1440x1080px · wide-field fundus photograph from neonatal ROP screening
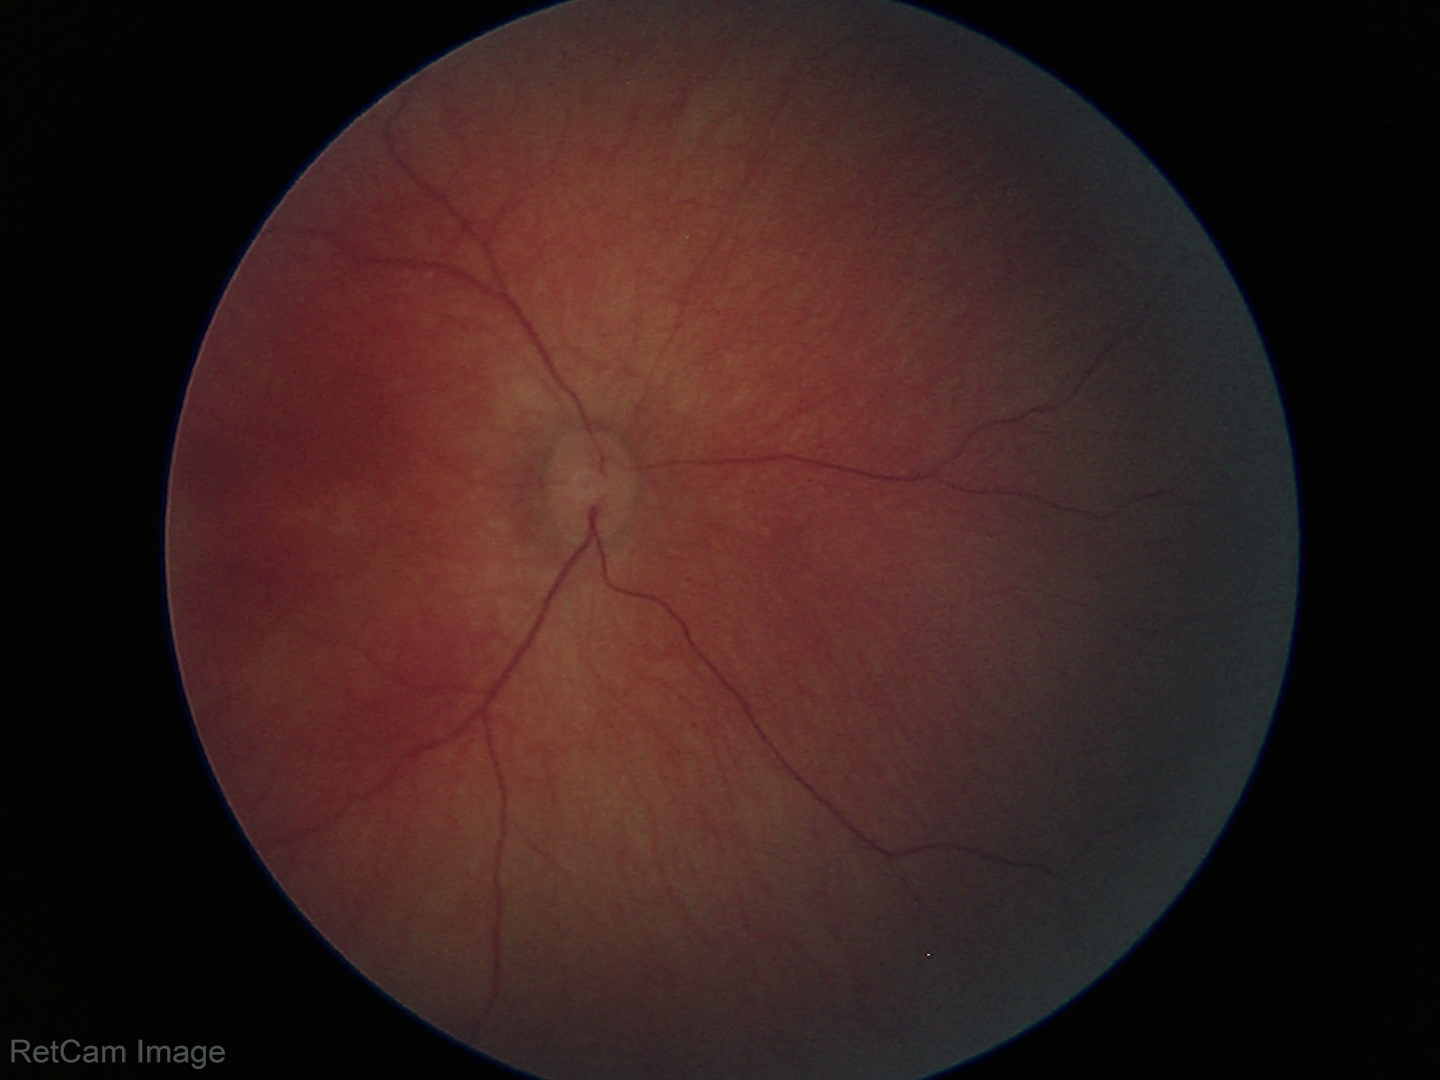 Assessment: normal retinal appearance